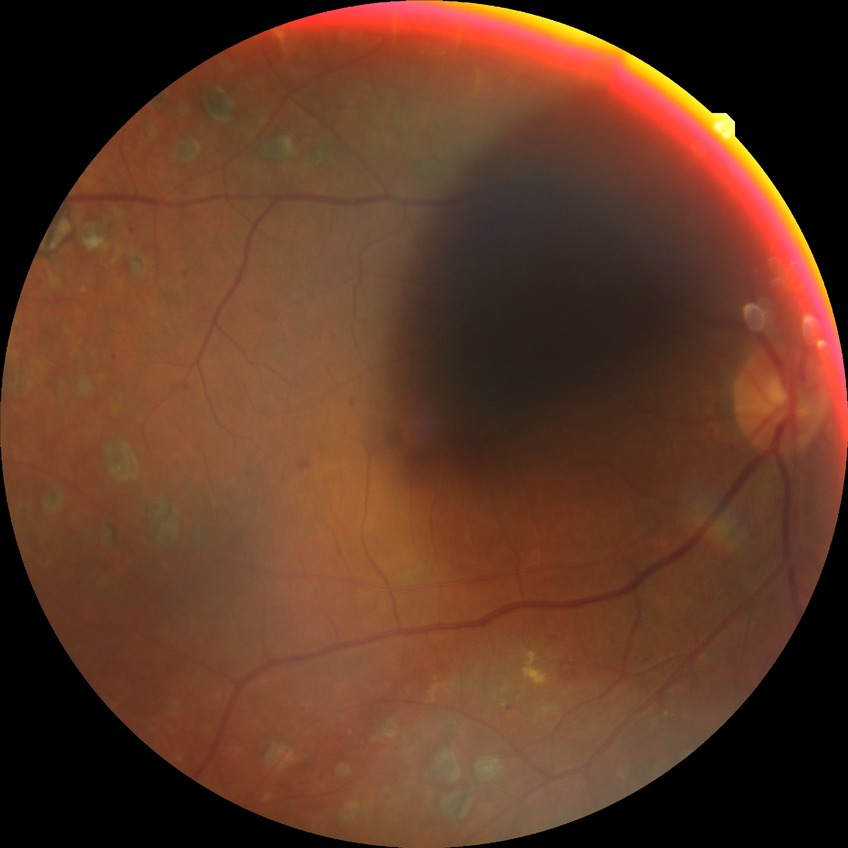 Diabetic retinopathy (DR): PDR (proliferative diabetic retinopathy).